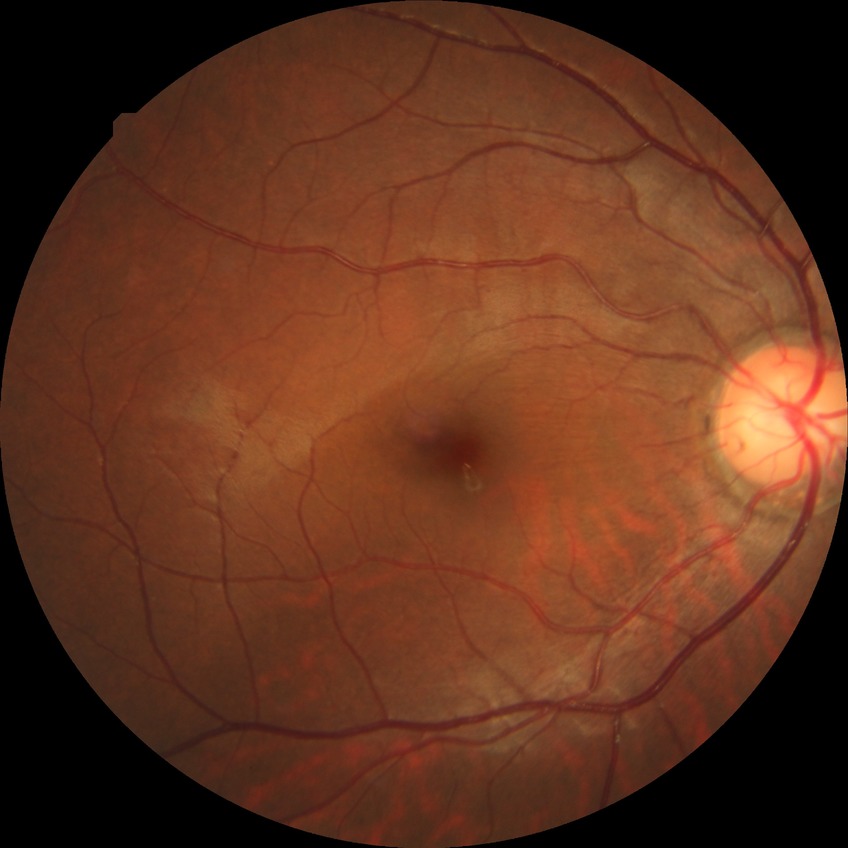
Diabetic retinopathy (DR): NDR (no diabetic retinopathy).